Wide-field fundus image from infant ROP screening. Image size 1240x1240. Phoenix ICON, 100° FOV.
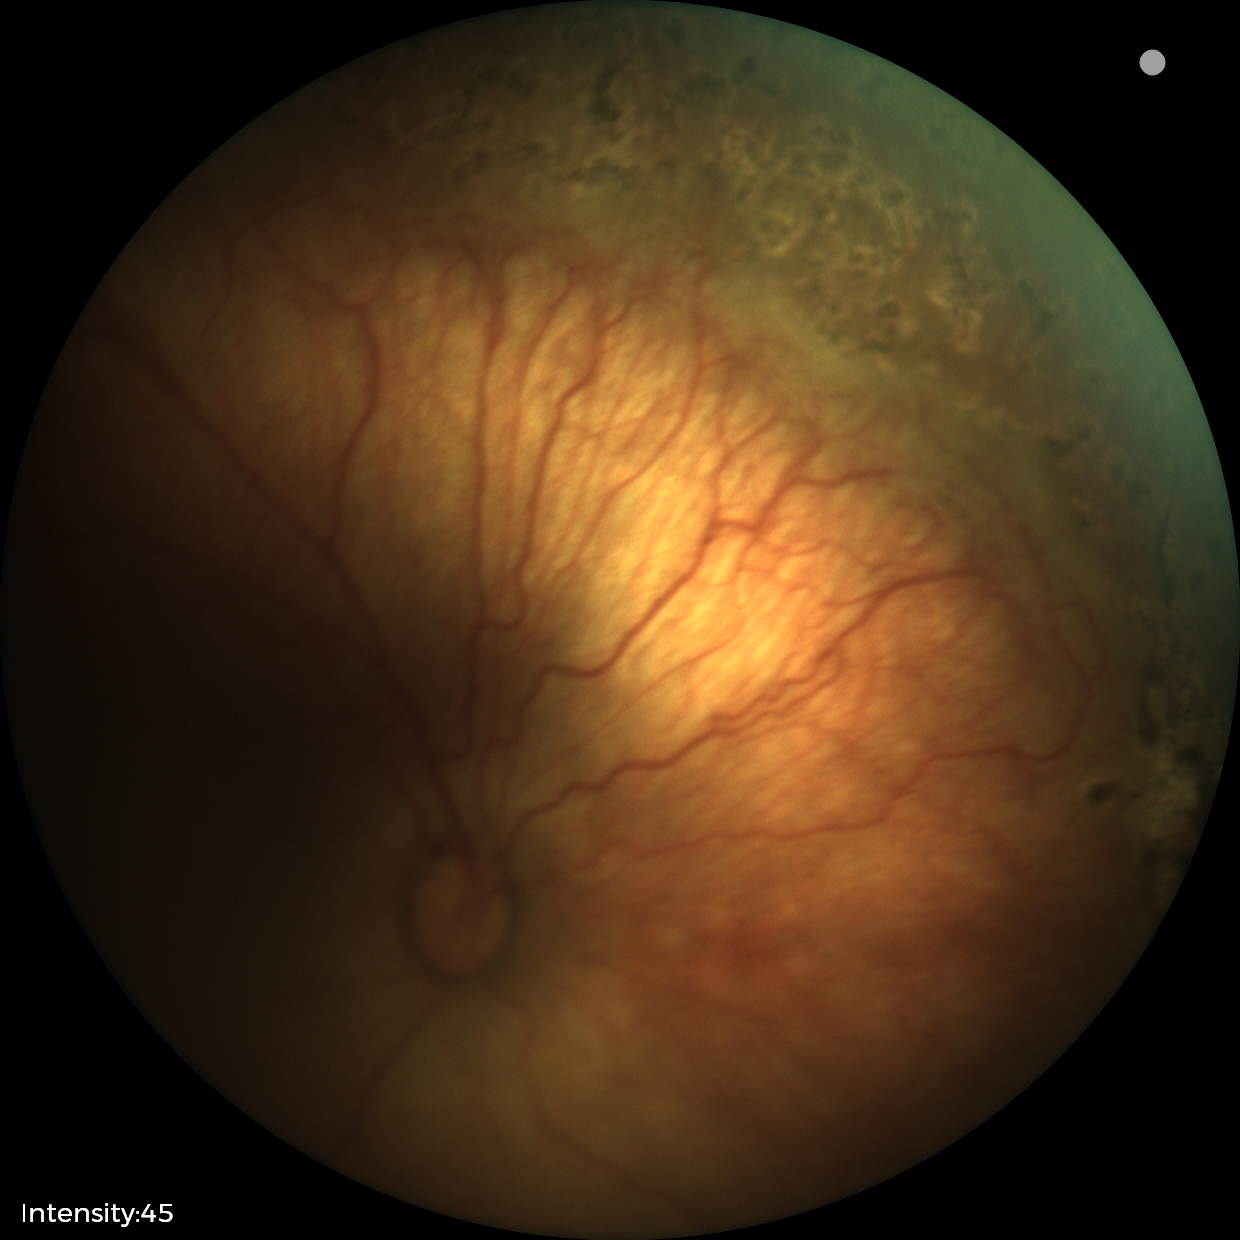
Plus disease absent.
Screening examination consistent with status post retinopathy of prematurity.